Davis DR grading, 45-degree field of view — 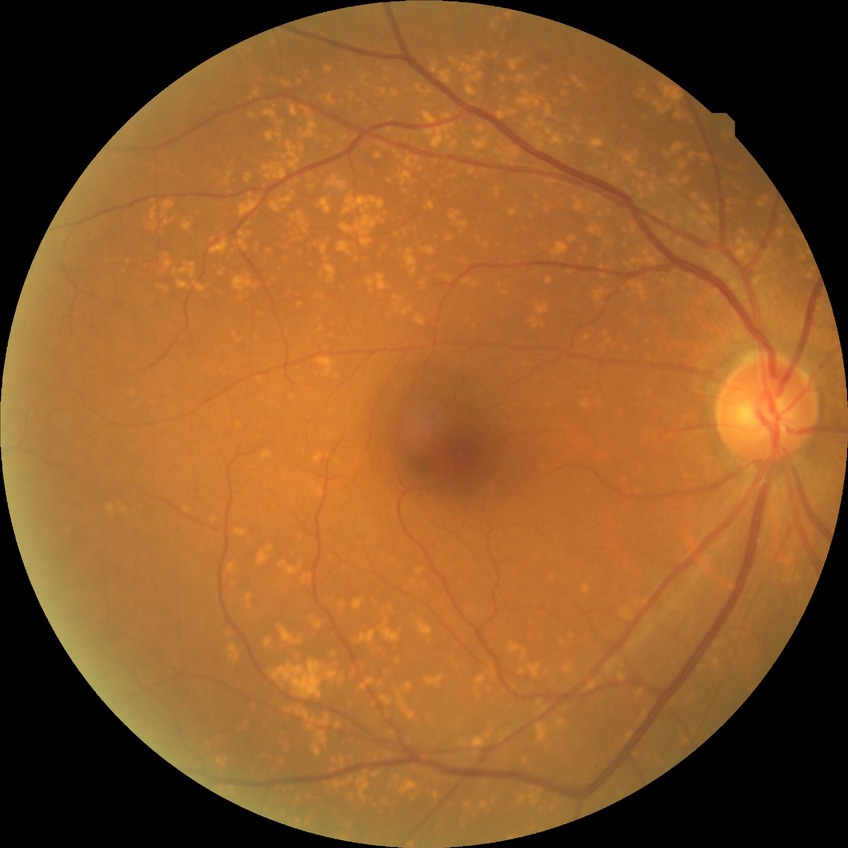

{
  "davis_grade": "no diabetic retinopathy"
}